848 by 848 pixels · NIDEK AFC-230 fundus camera: 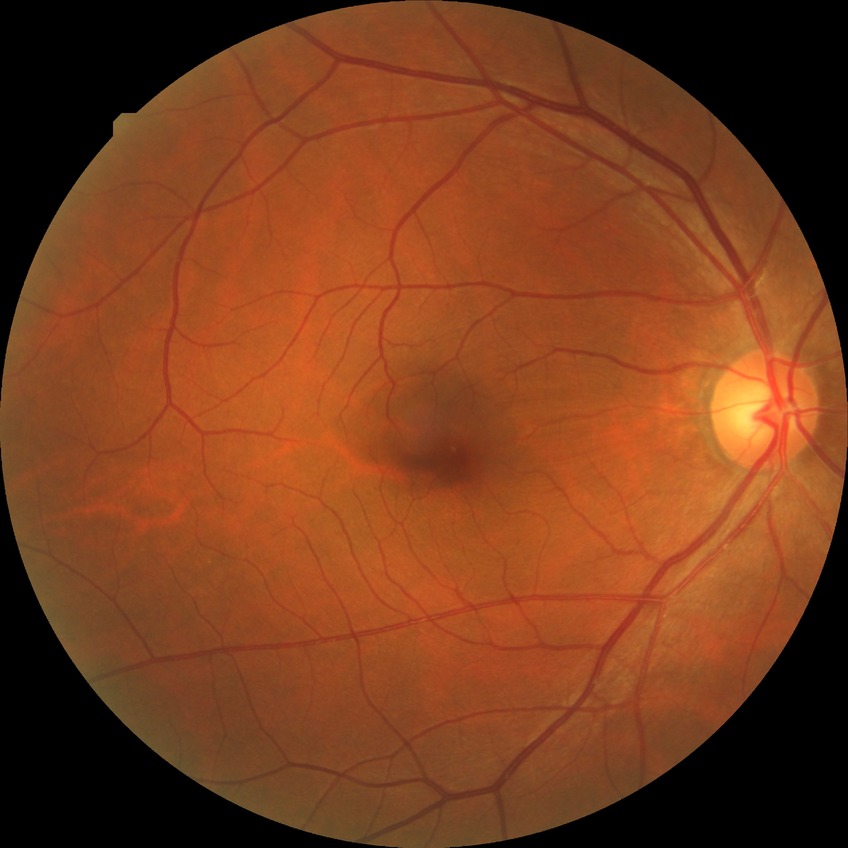 Diabetic retinopathy severity: no diabetic retinopathy.